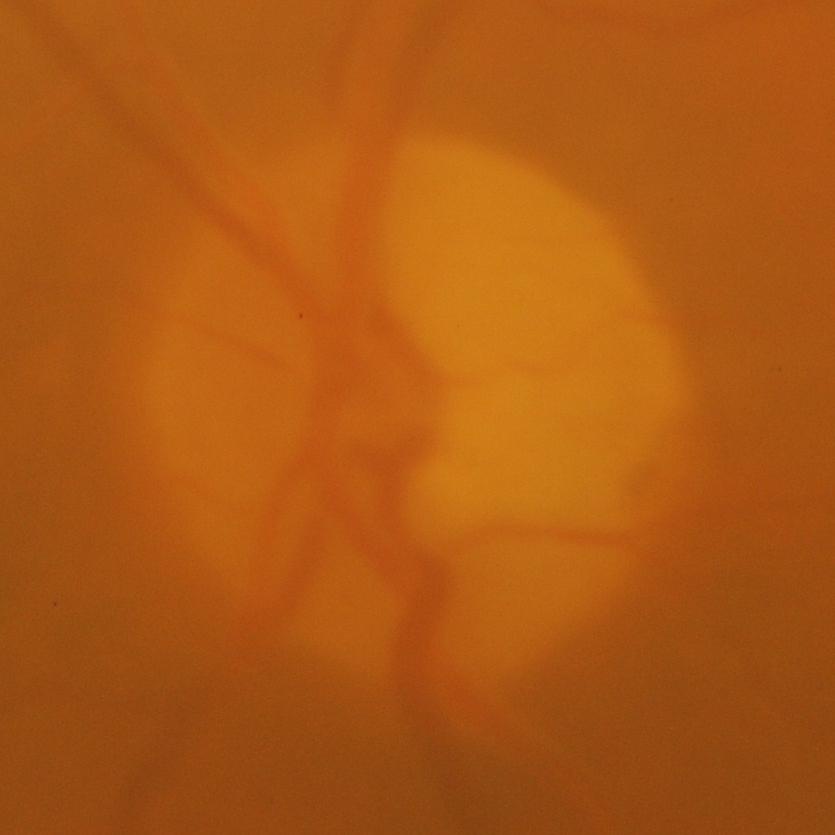

Q: Glaucoma assessment?
A: Glaucomatous changes.